Acquired with a Remidio smartphone fundus camera
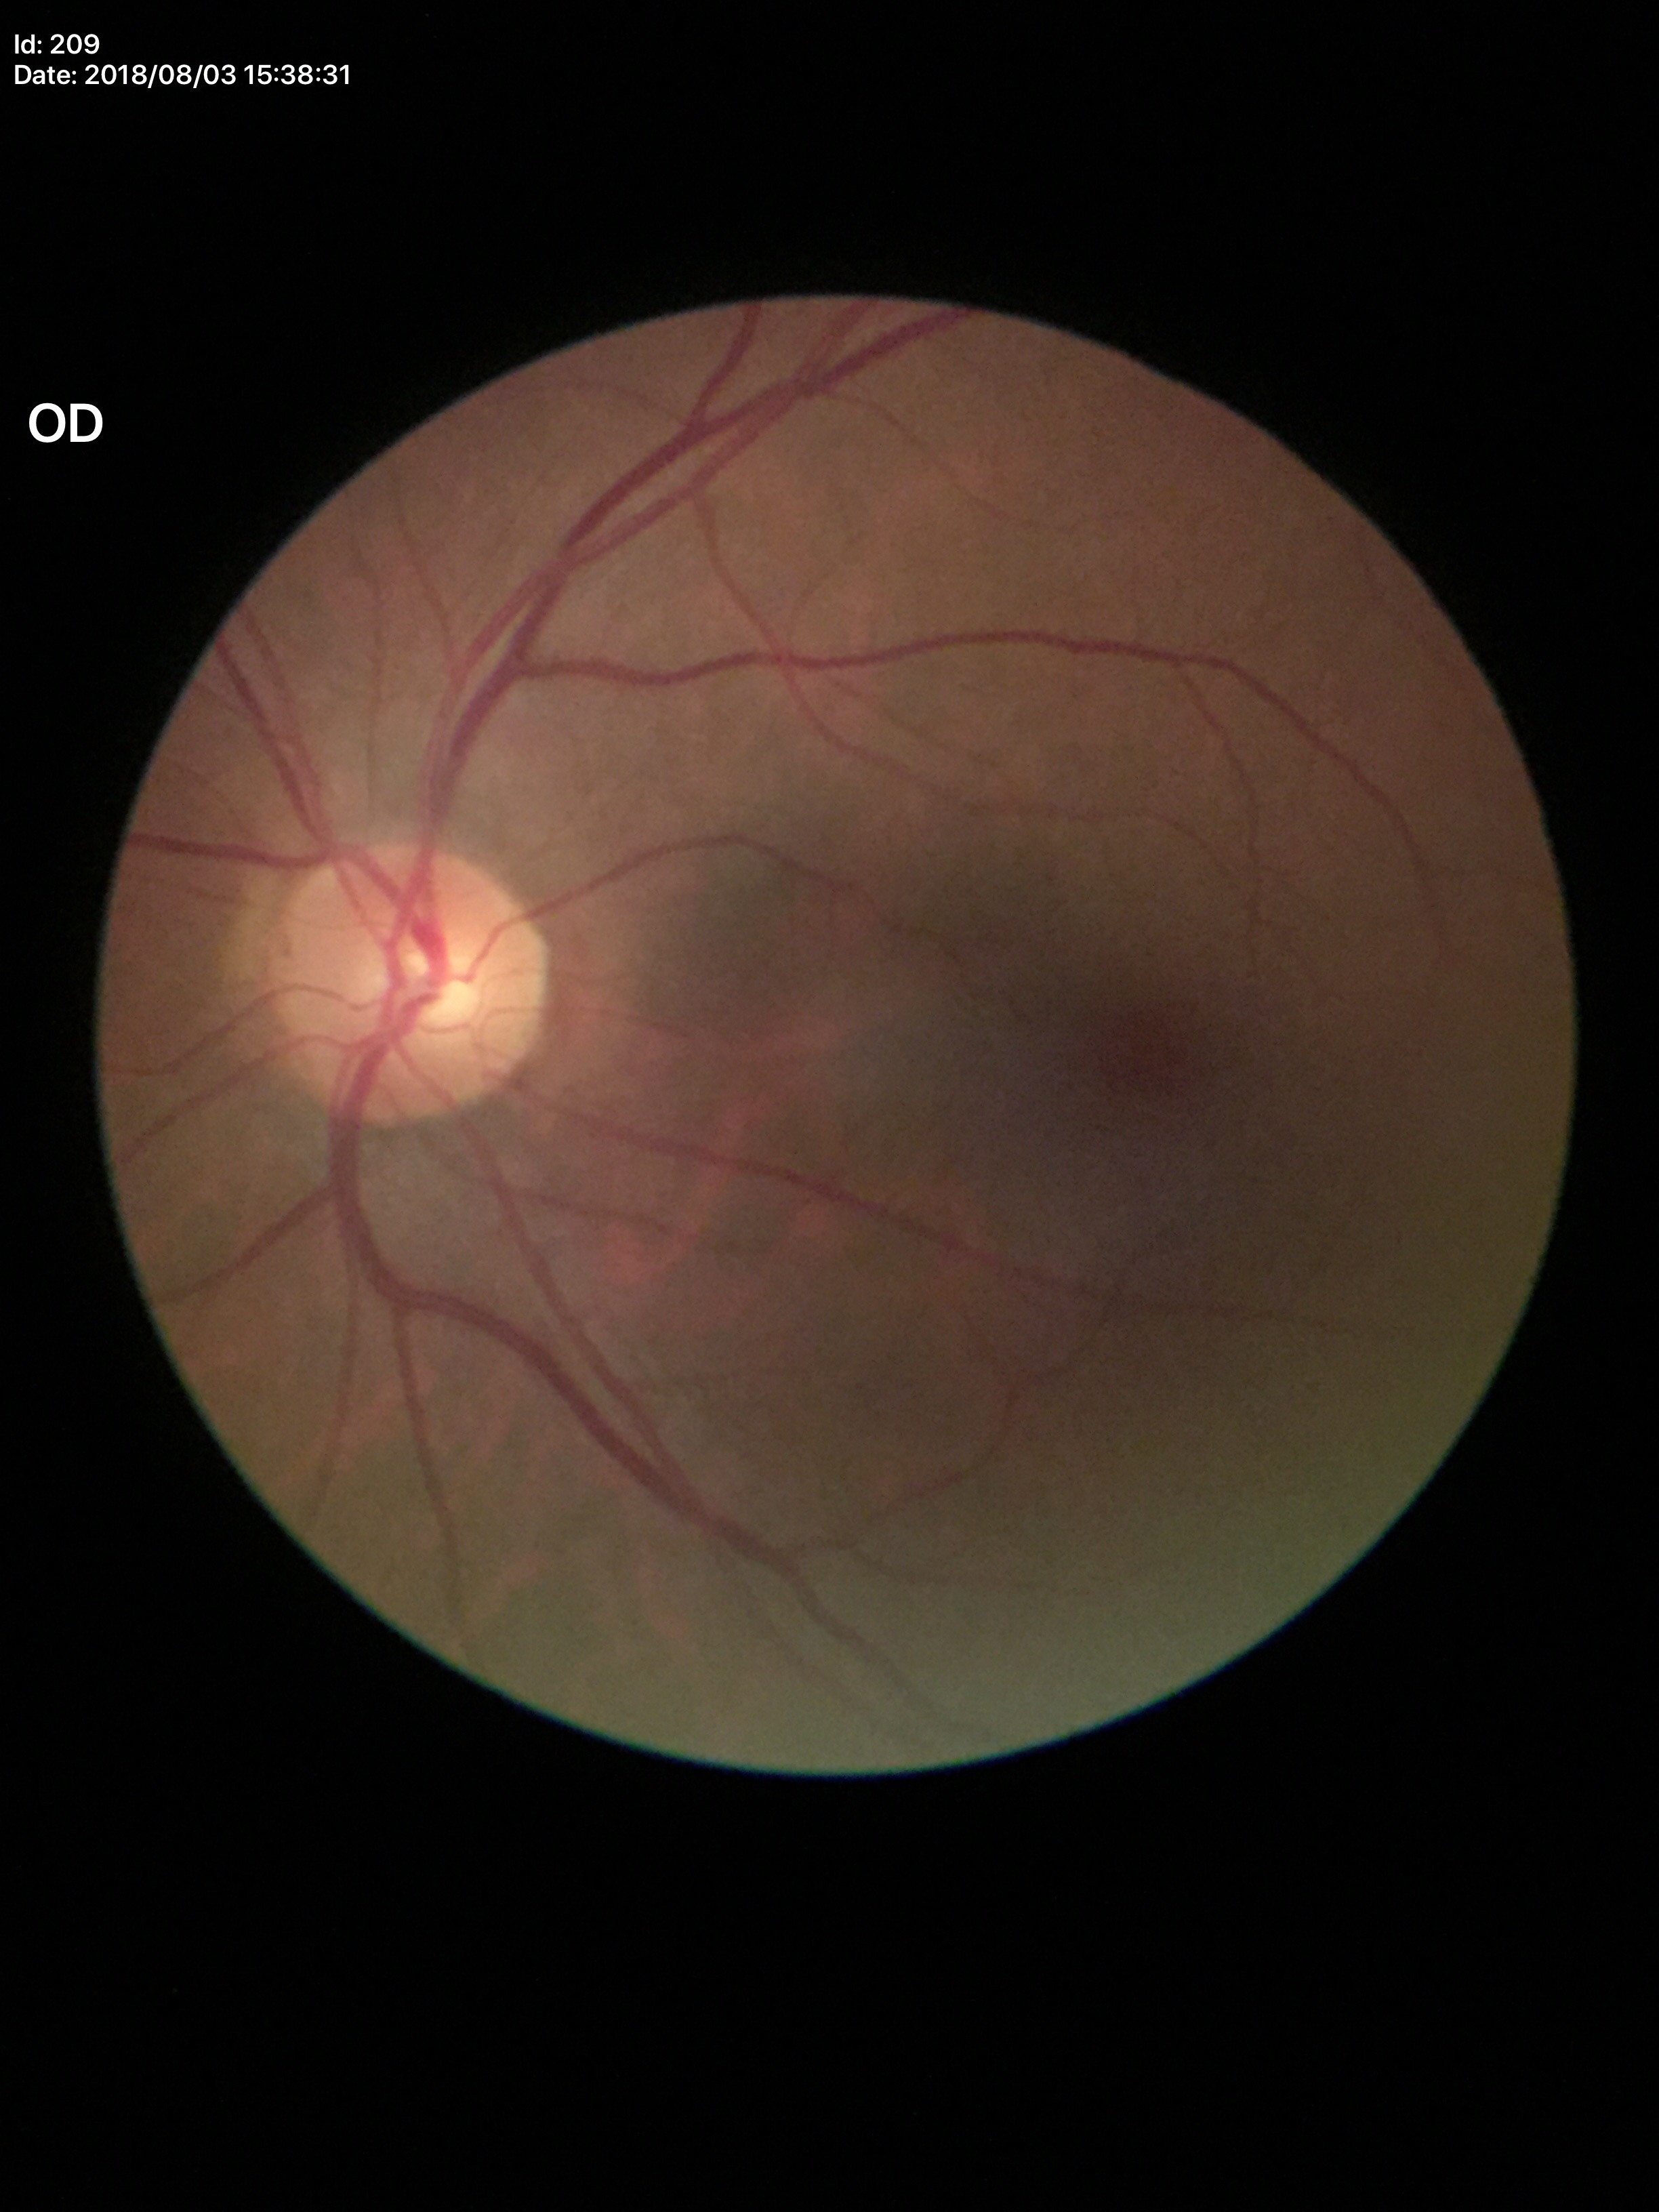
{
  "vcdr": "0.53",
  "hcdr": "0.54",
  "glaucoma_decision": "not suspect"
}